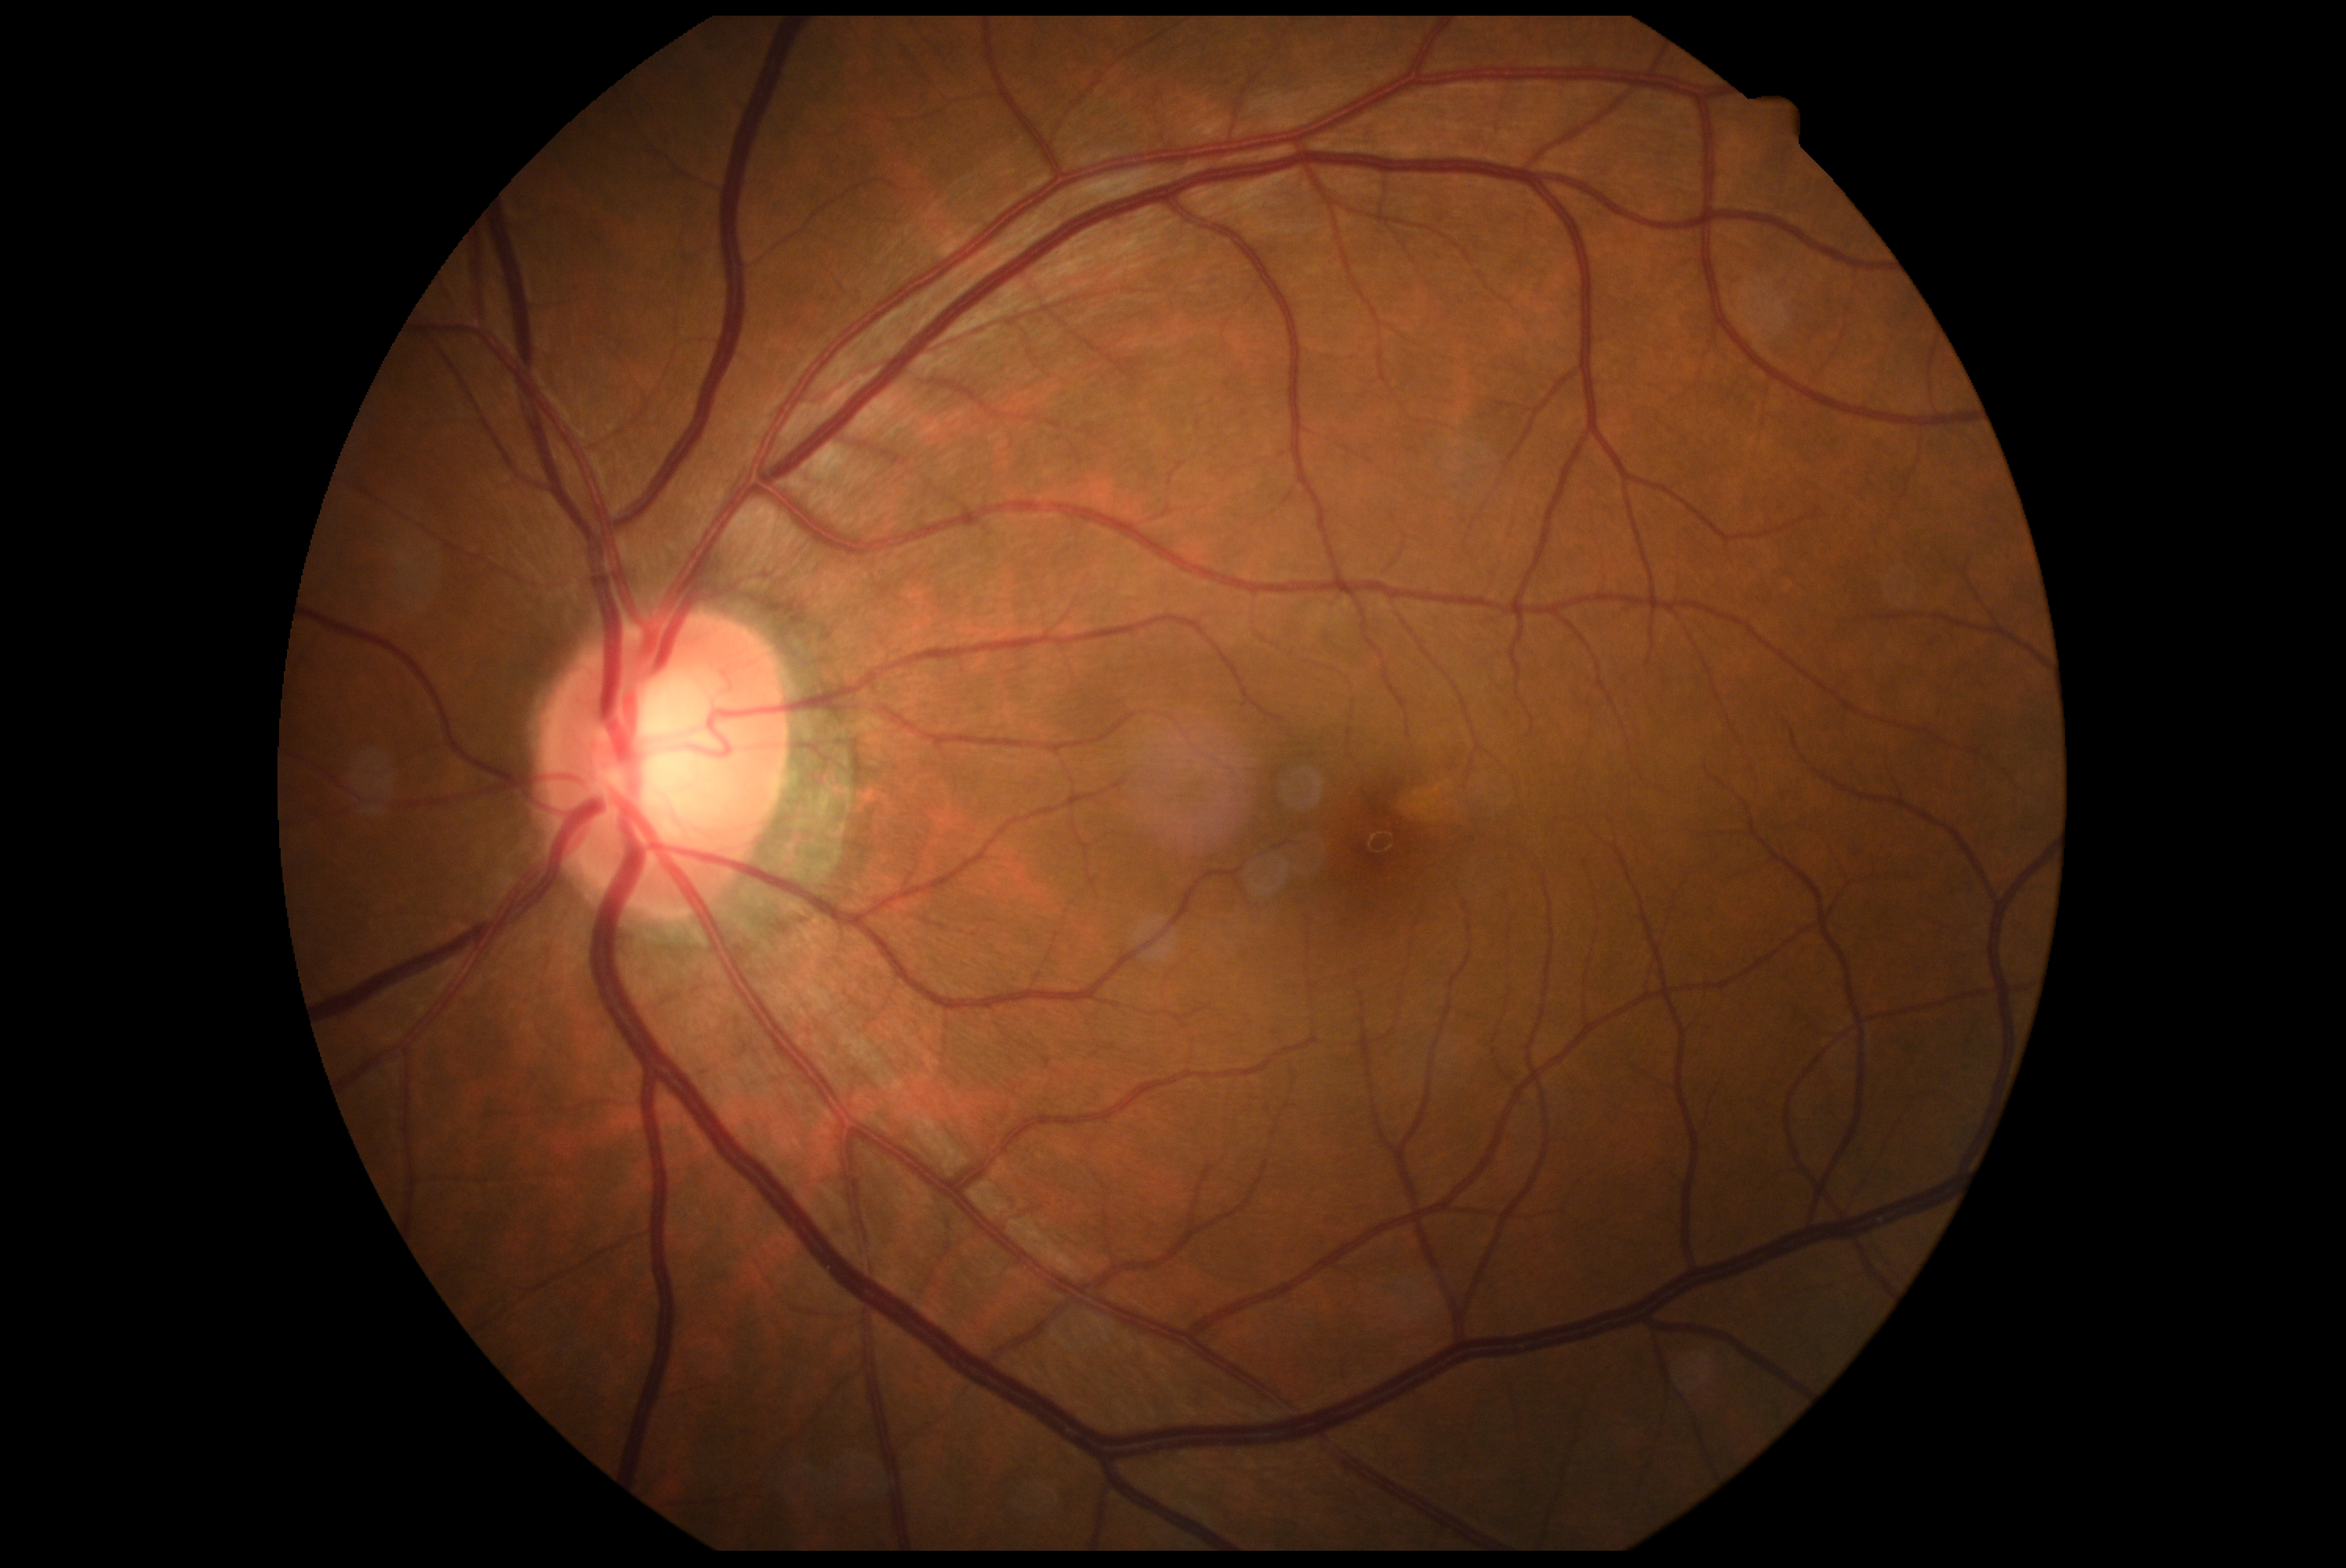 DR: grade 0 (no apparent retinopathy). No signs of diabetic retinopathy.